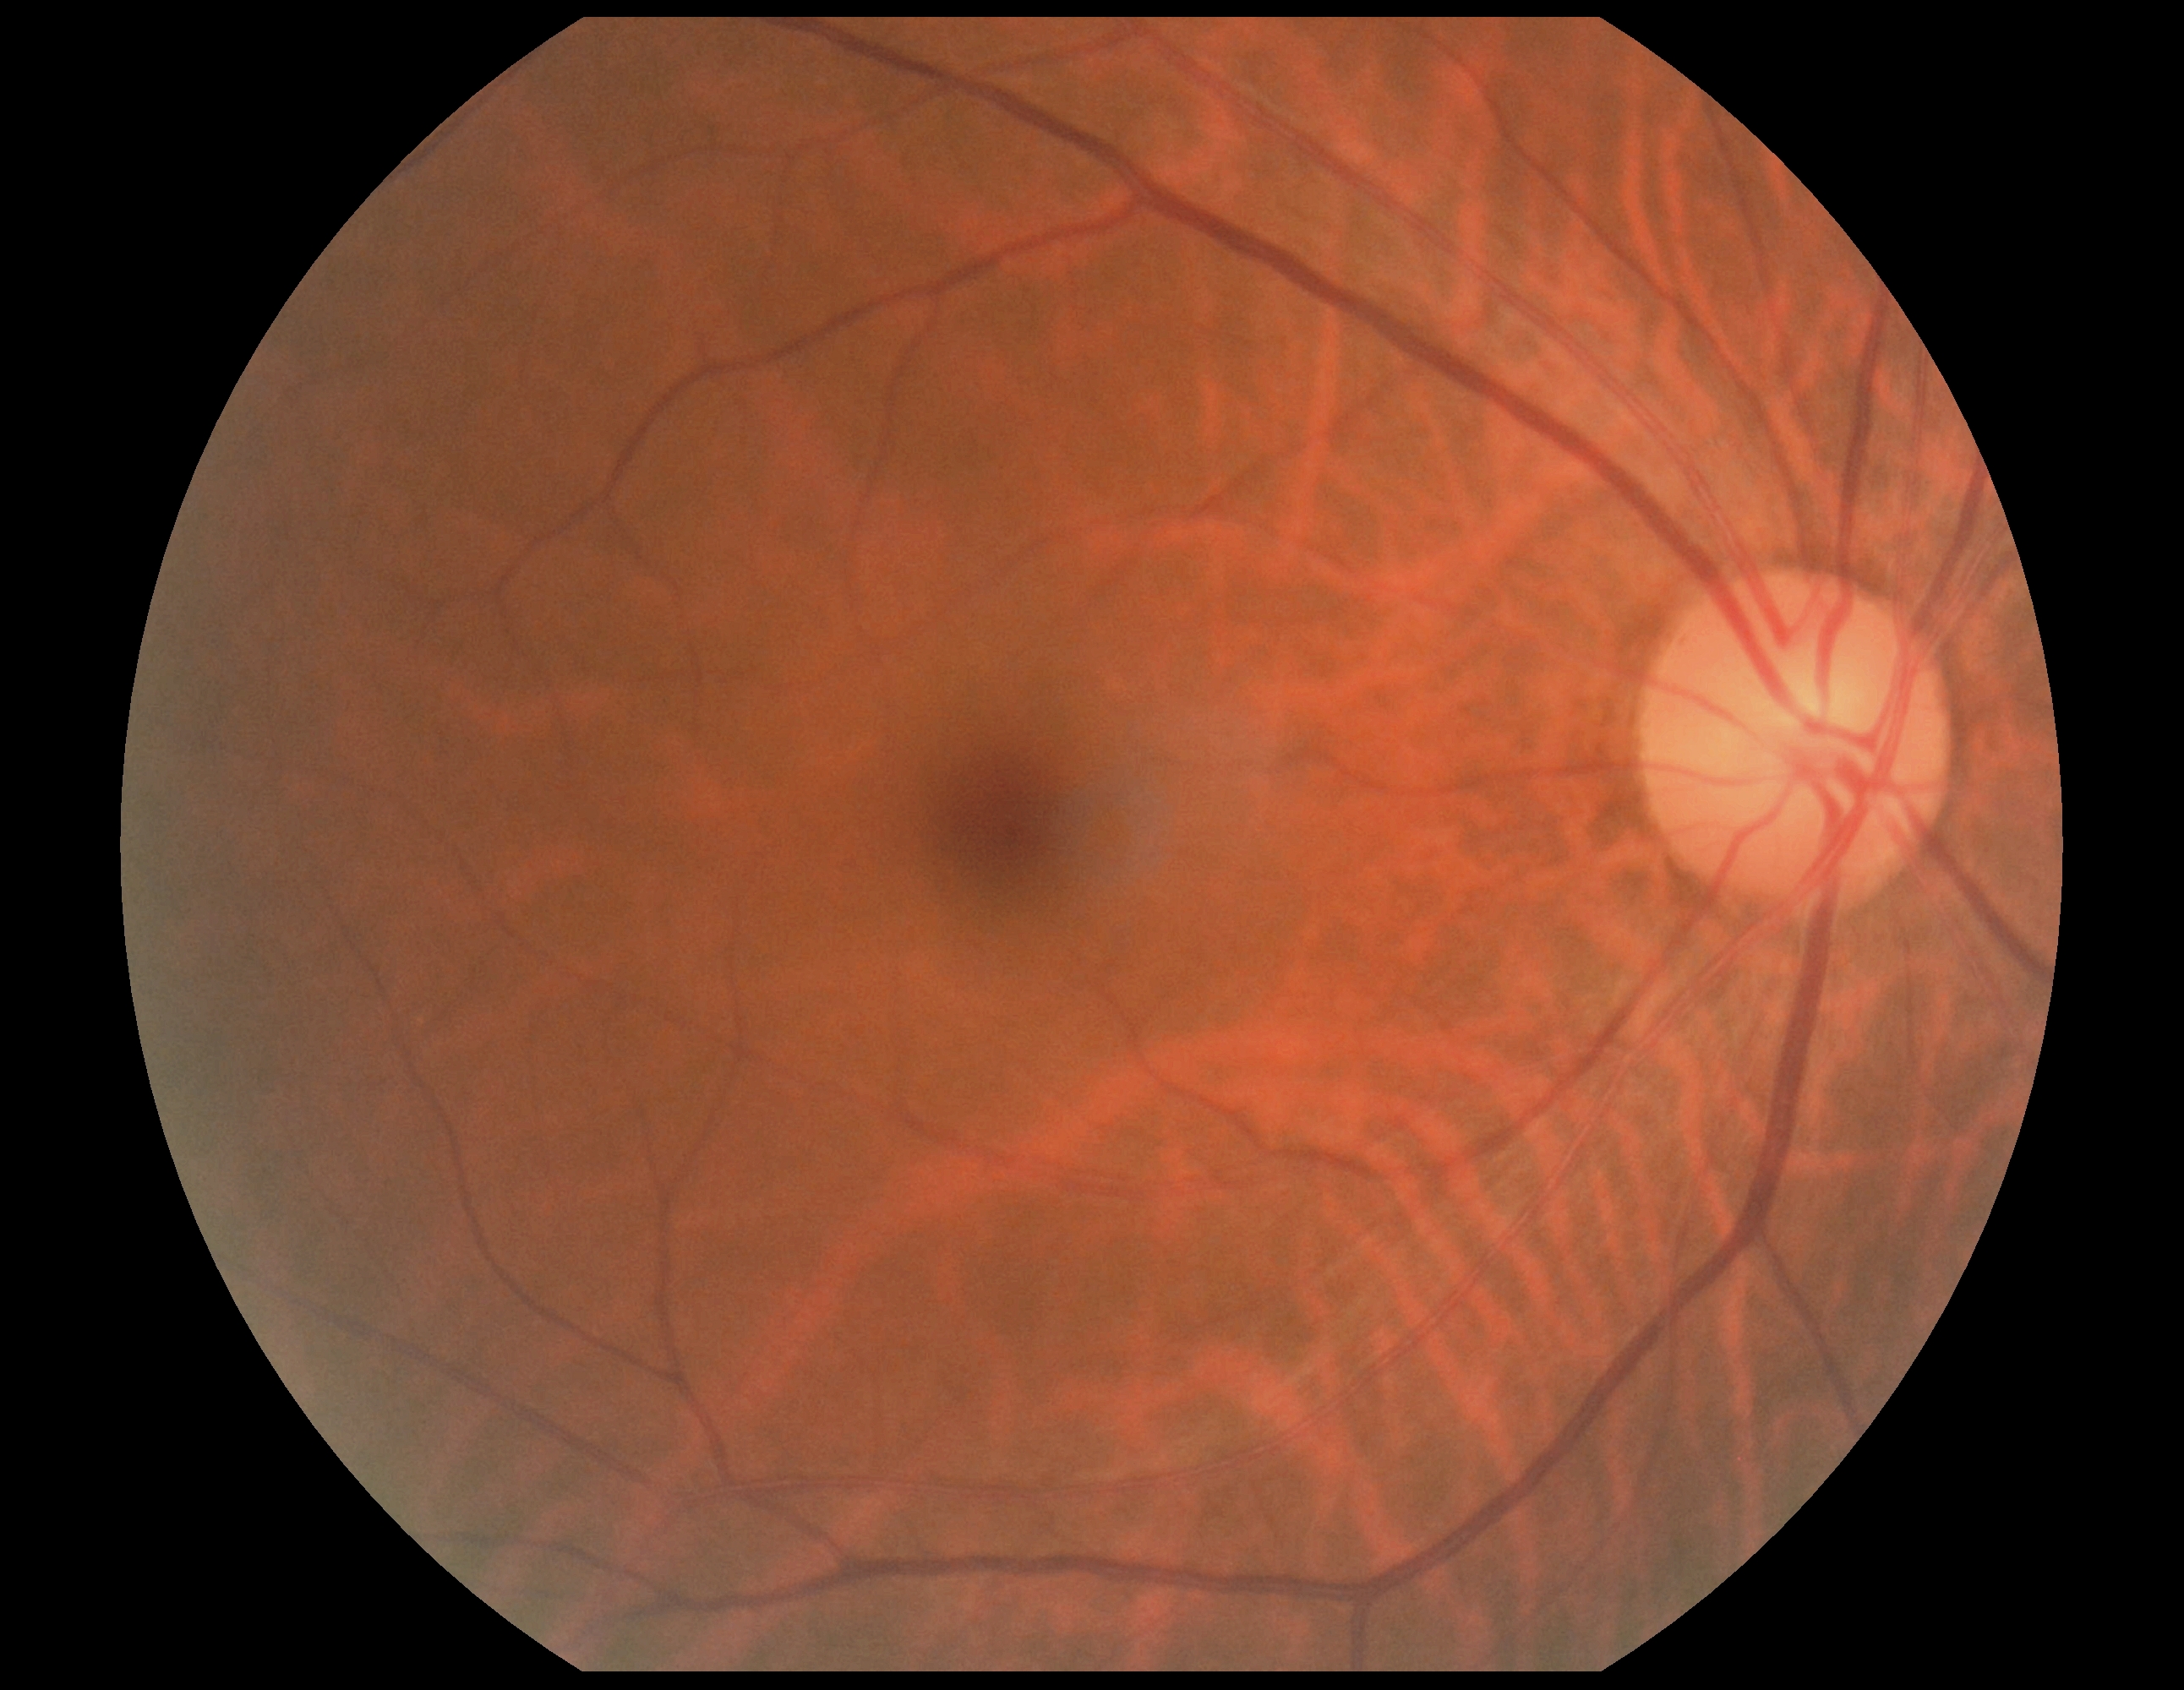

Retinopathy grade: 0.